DR severity per modified Davis staging:
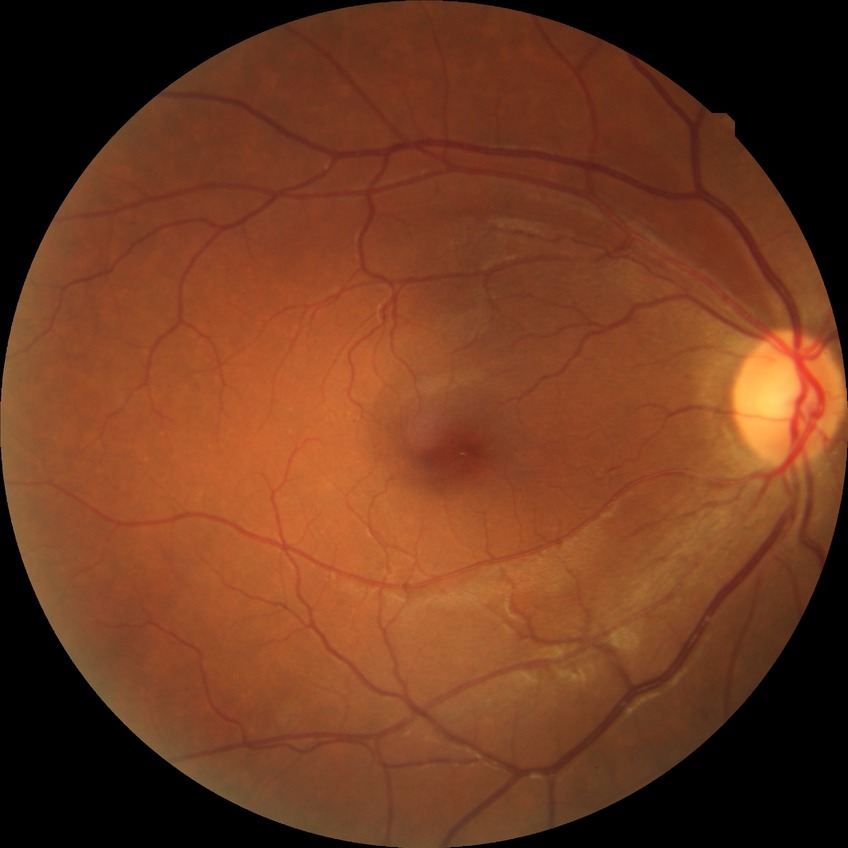 Diabetic retinopathy (DR): no diabetic retinopathy (NDR).